Camera: NIDEK AFC-230 — 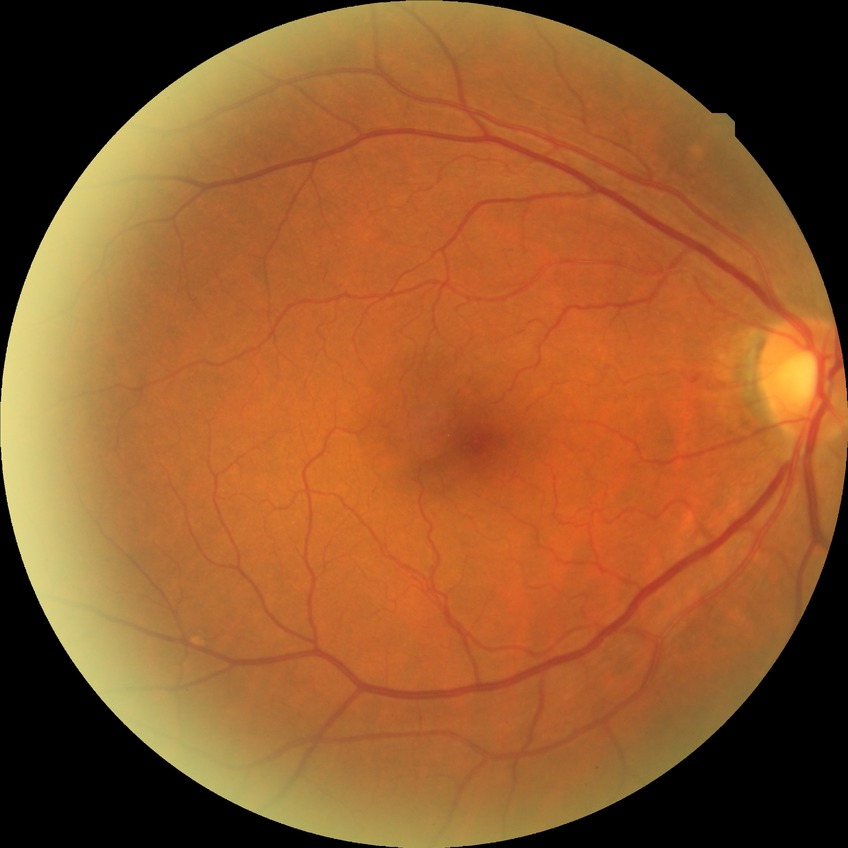
diabetic retinopathy grade: no diabetic retinopathy.